UWF retinal mosaic. 1924 x 1556 pixels:
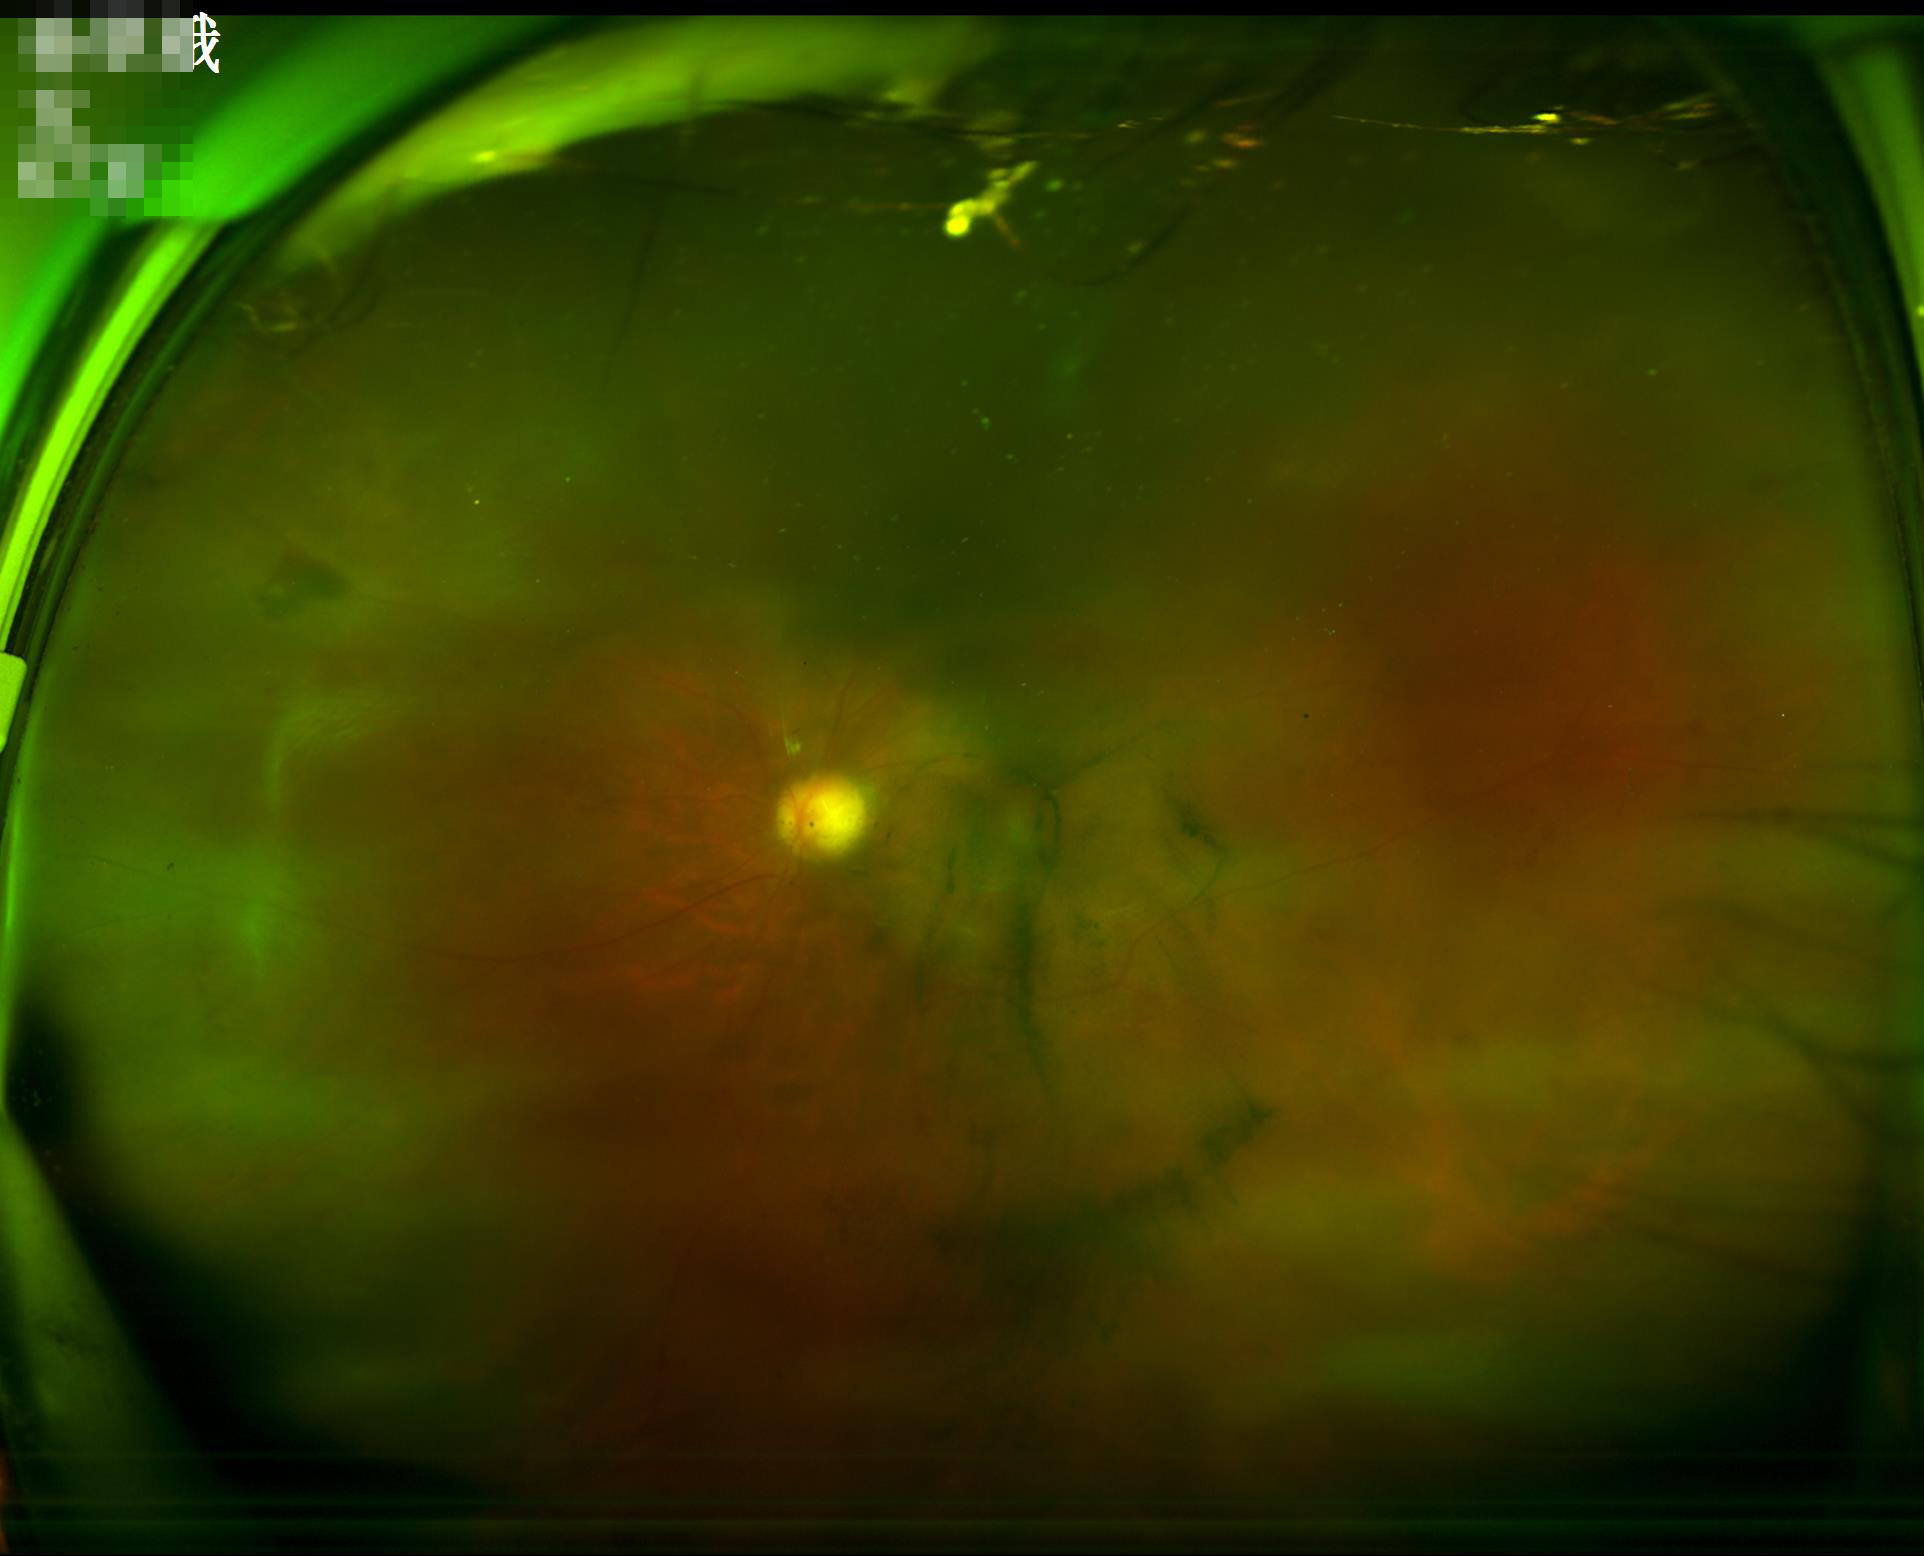 Contrast is low. Image quality is suboptimal. Noticeable blur in the optic disc, vessels, or background. Illumination and color are suboptimal.